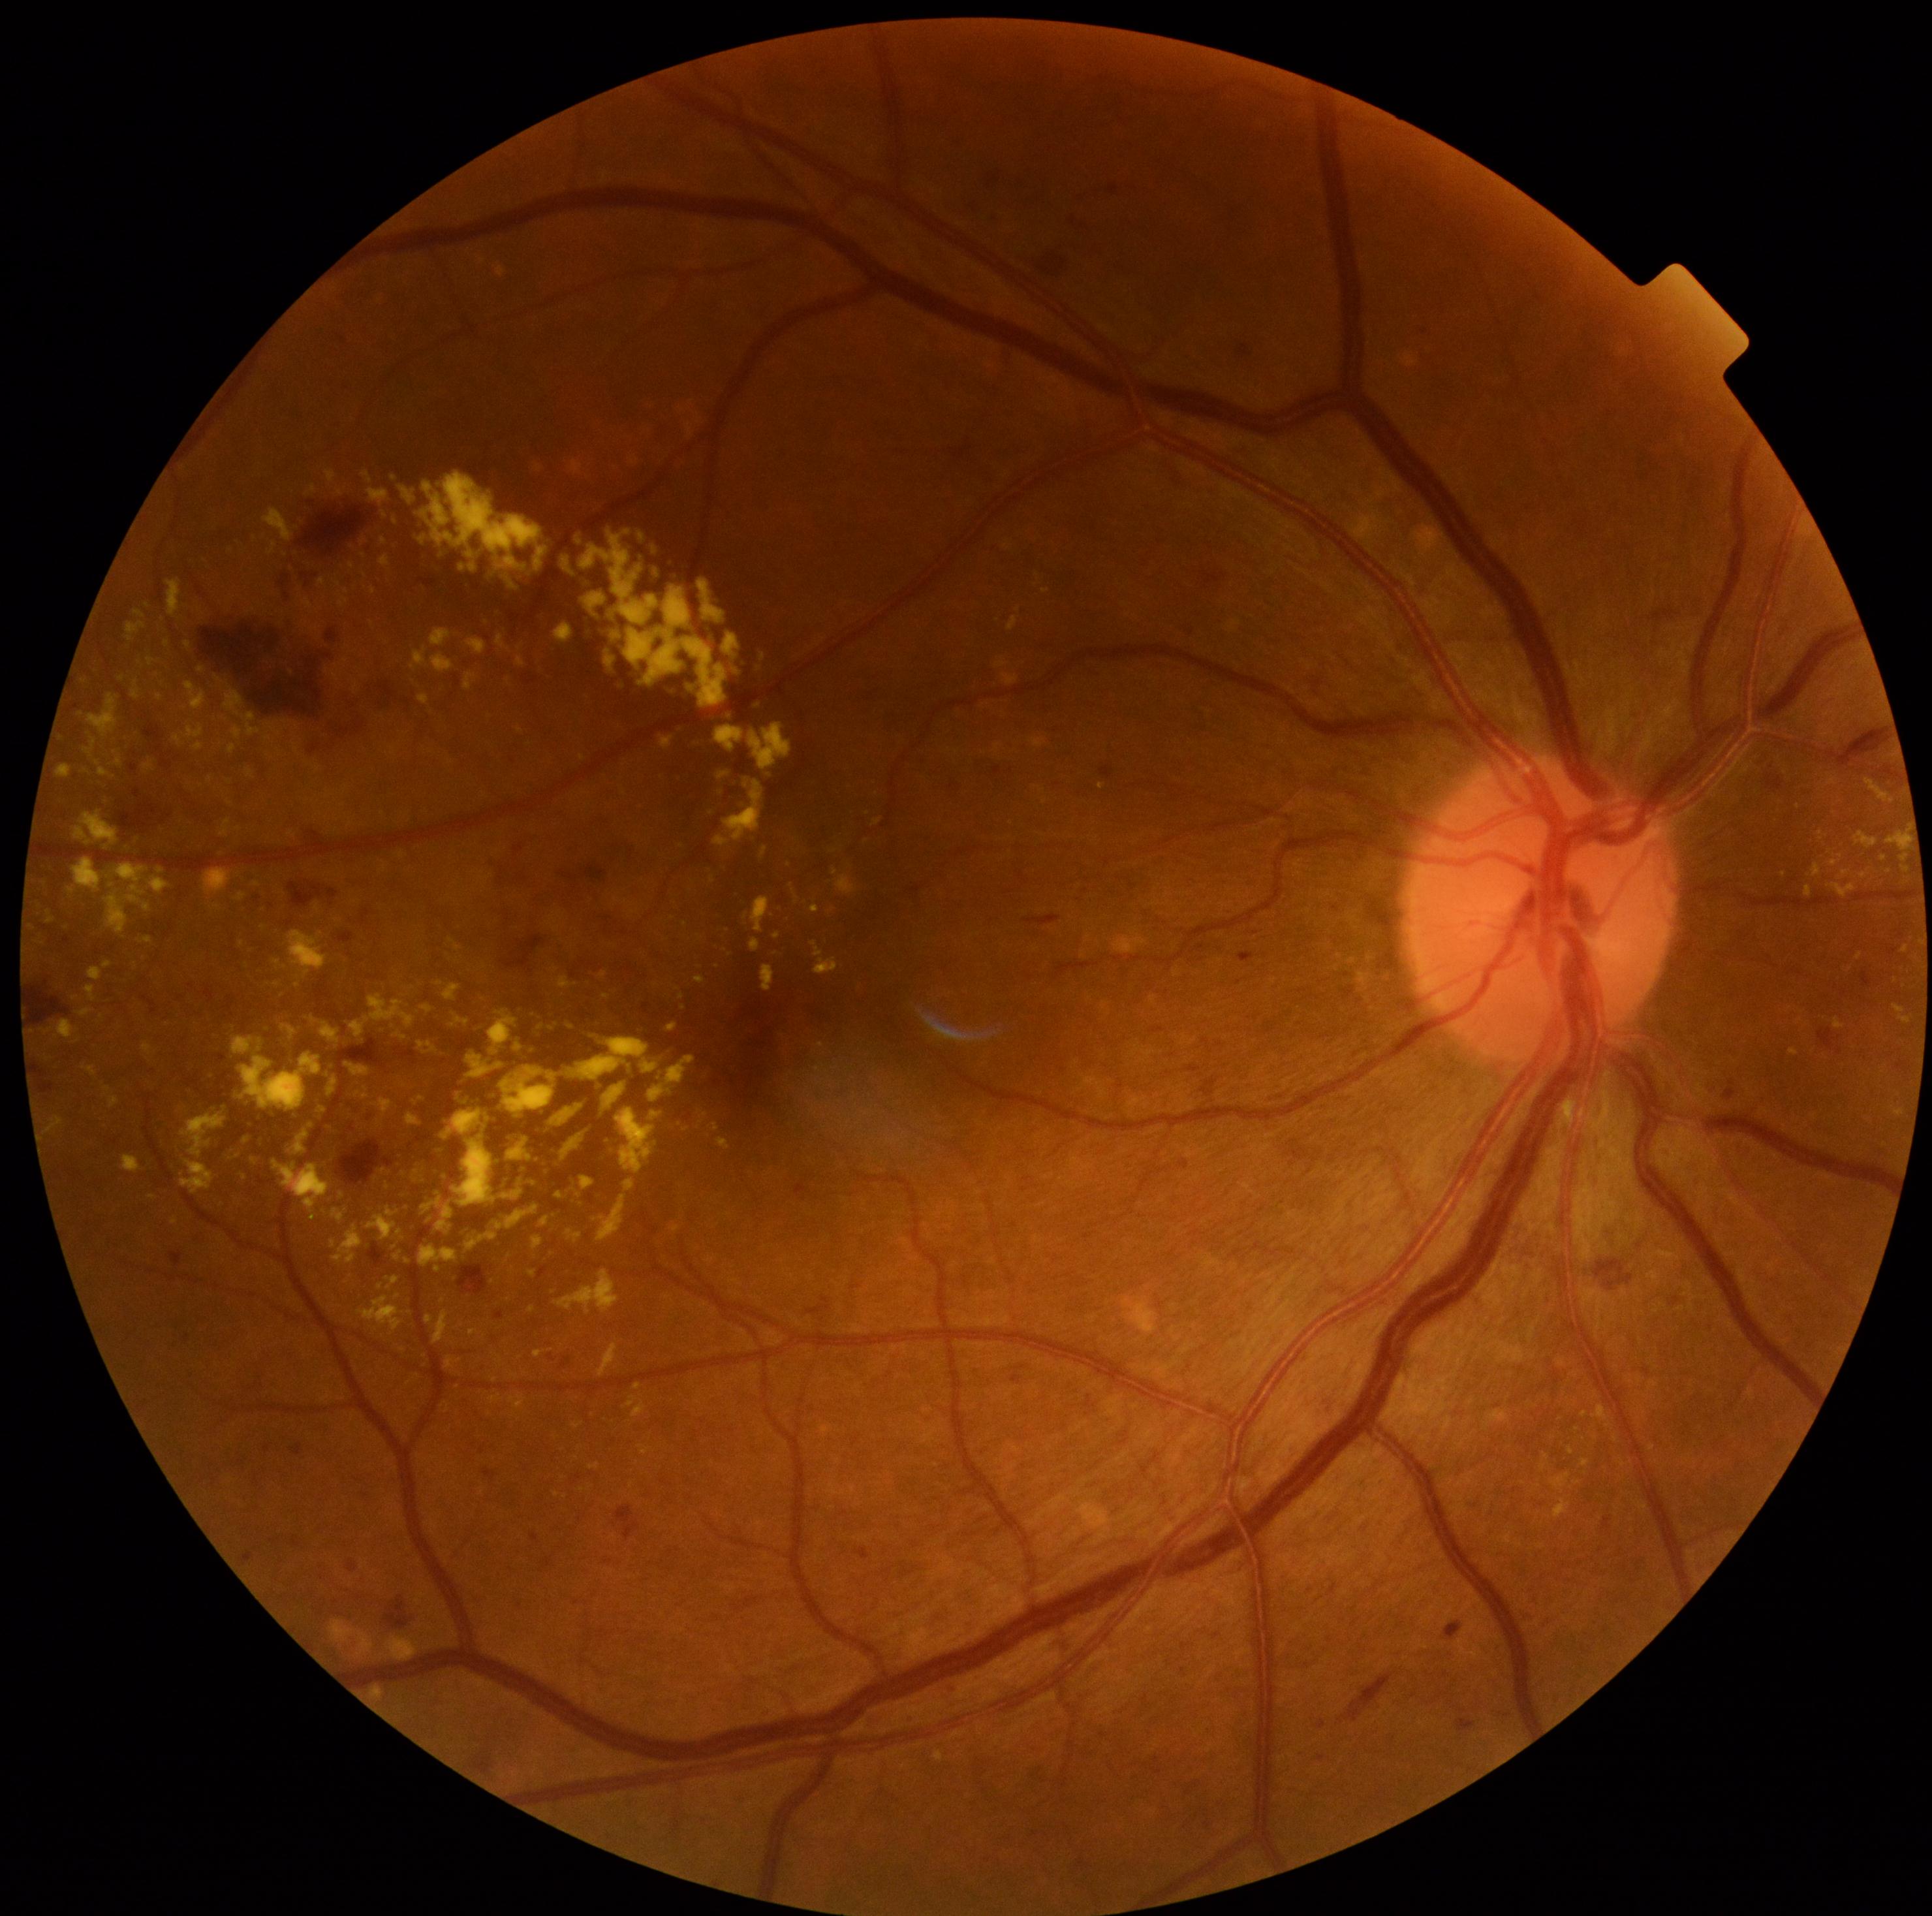
Diabetic retinopathy: grade 2 (moderate NPDR). Hard exudates are present, including at bbox=(264, 721, 287, 736) | bbox=(207, 776, 215, 785) | bbox=(450, 939, 463, 952) | bbox=(724, 633, 740, 659) | bbox=(203, 868, 233, 896) | bbox=(116, 756, 125, 768) | bbox=(339, 1192, 345, 1200) | bbox=(287, 930, 328, 981) | bbox=(477, 872, 491, 887) | bbox=(381, 555, 391, 568) | bbox=(215, 676, 224, 682) | bbox=(469, 564, 477, 572) | bbox=(760, 847, 768, 859). Hard exudates (small, approximate centers) near (494; 1380) | (230; 783) | (858; 1386) | (1547; 1456) | (701; 938) | (82; 715) | (397; 1296).